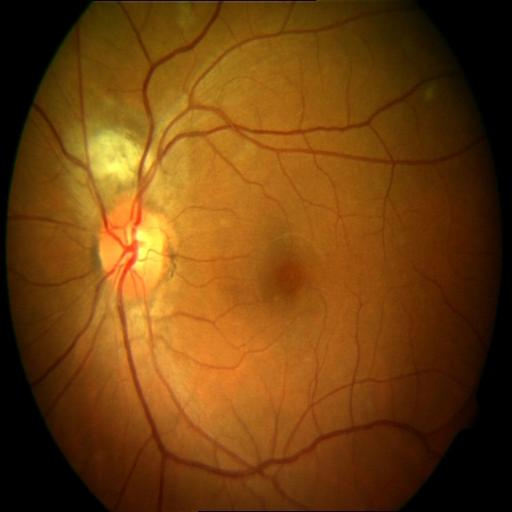

Retinal fundus photograph demonstrating chorioretinitis.